1923 x 1932 pixels · fundus photo:
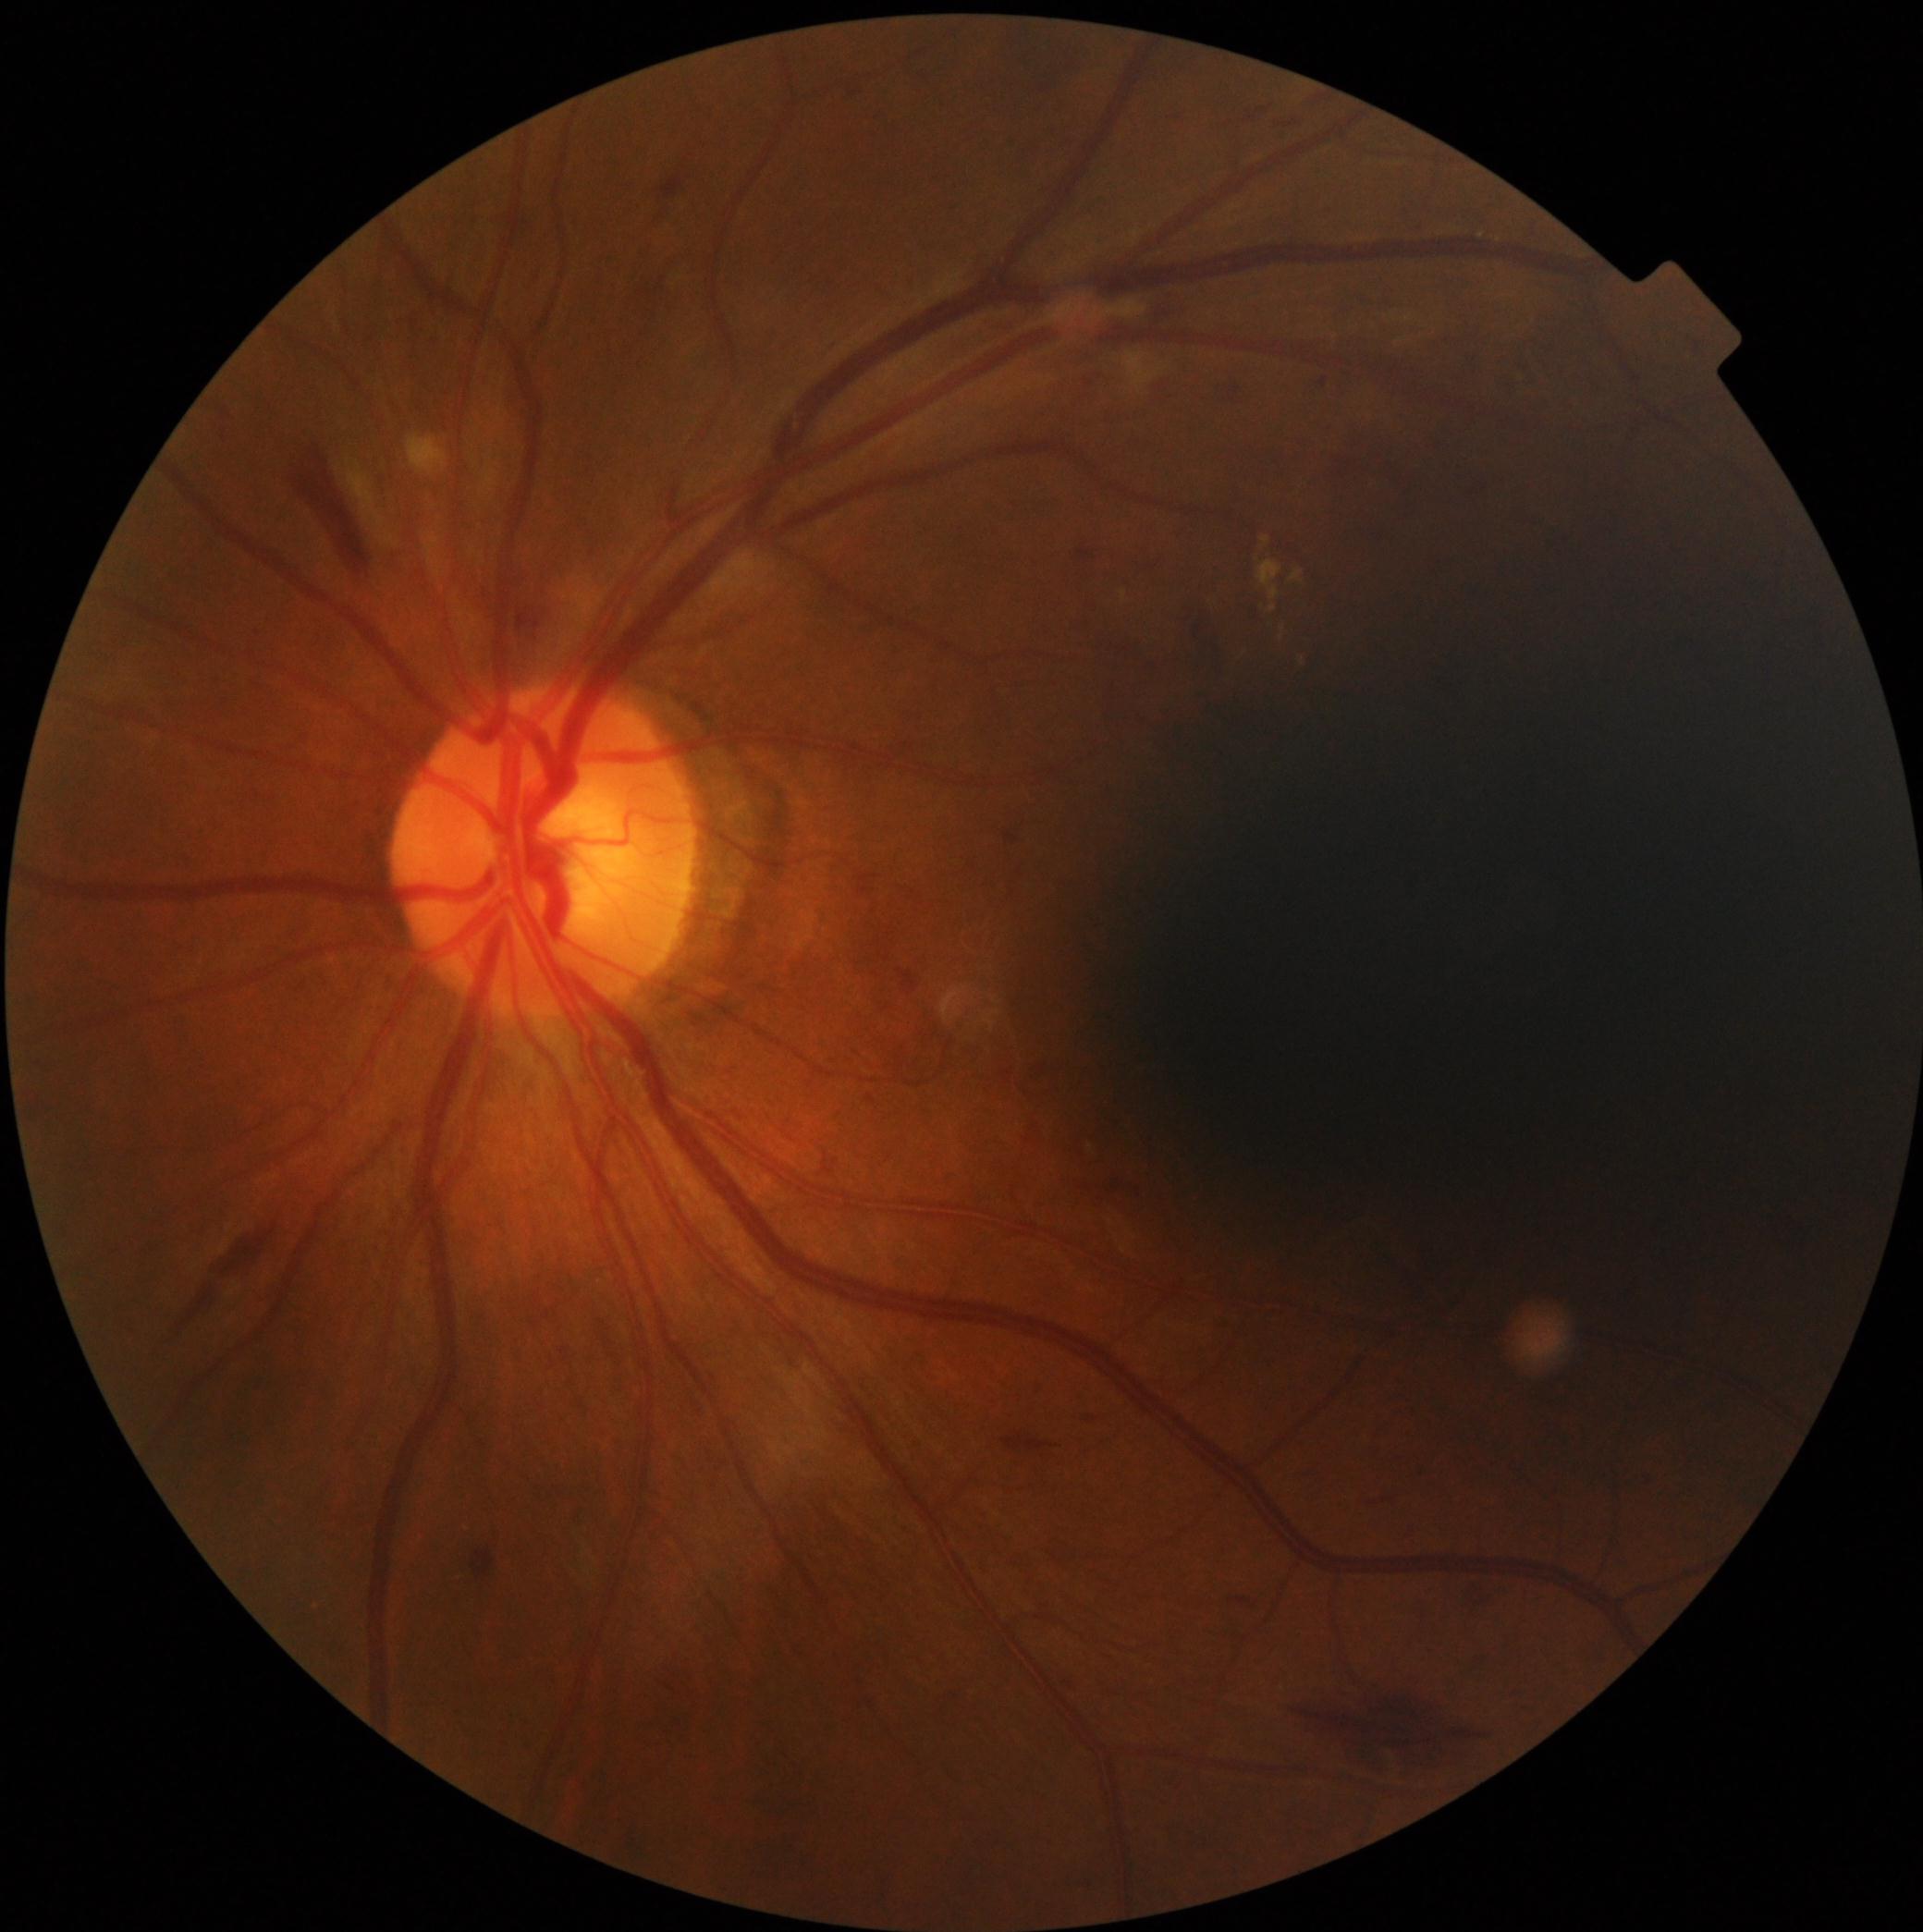 – DR class: non-proliferative diabetic retinopathy
– diabetic retinopathy severity: moderate non-proliferative diabetic retinopathy (grade 2)